Wide-field contact fundus photograph of an infant: 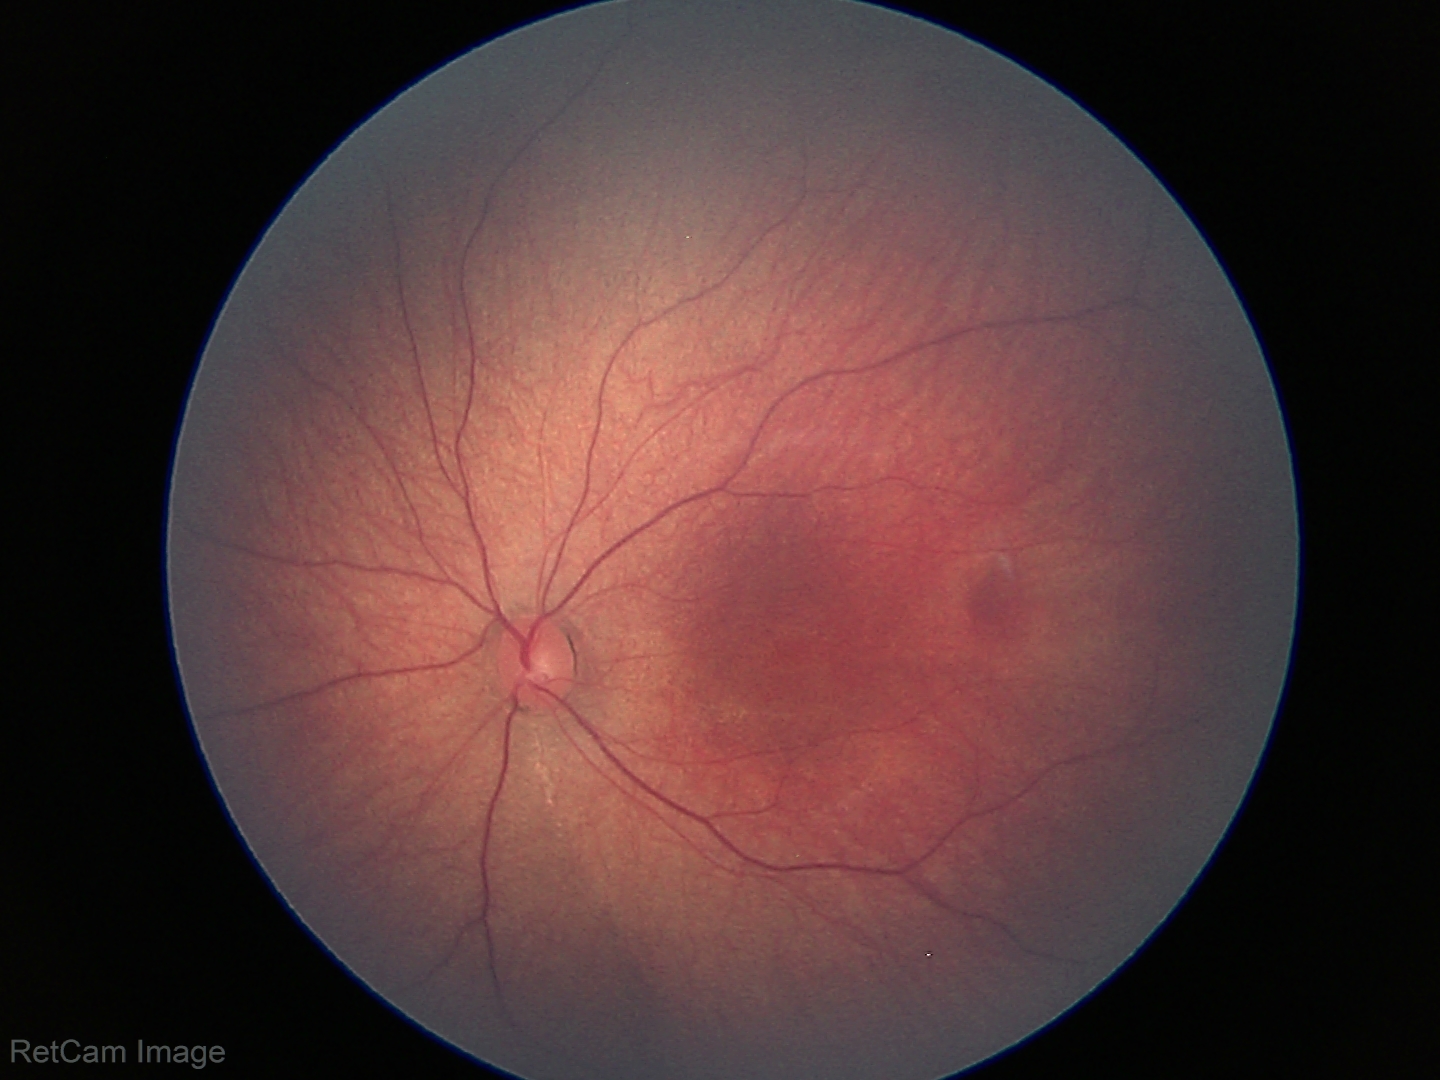
No retinal pathology identified on screening.